45-degree field of view; fundus photo; 2212x1672px
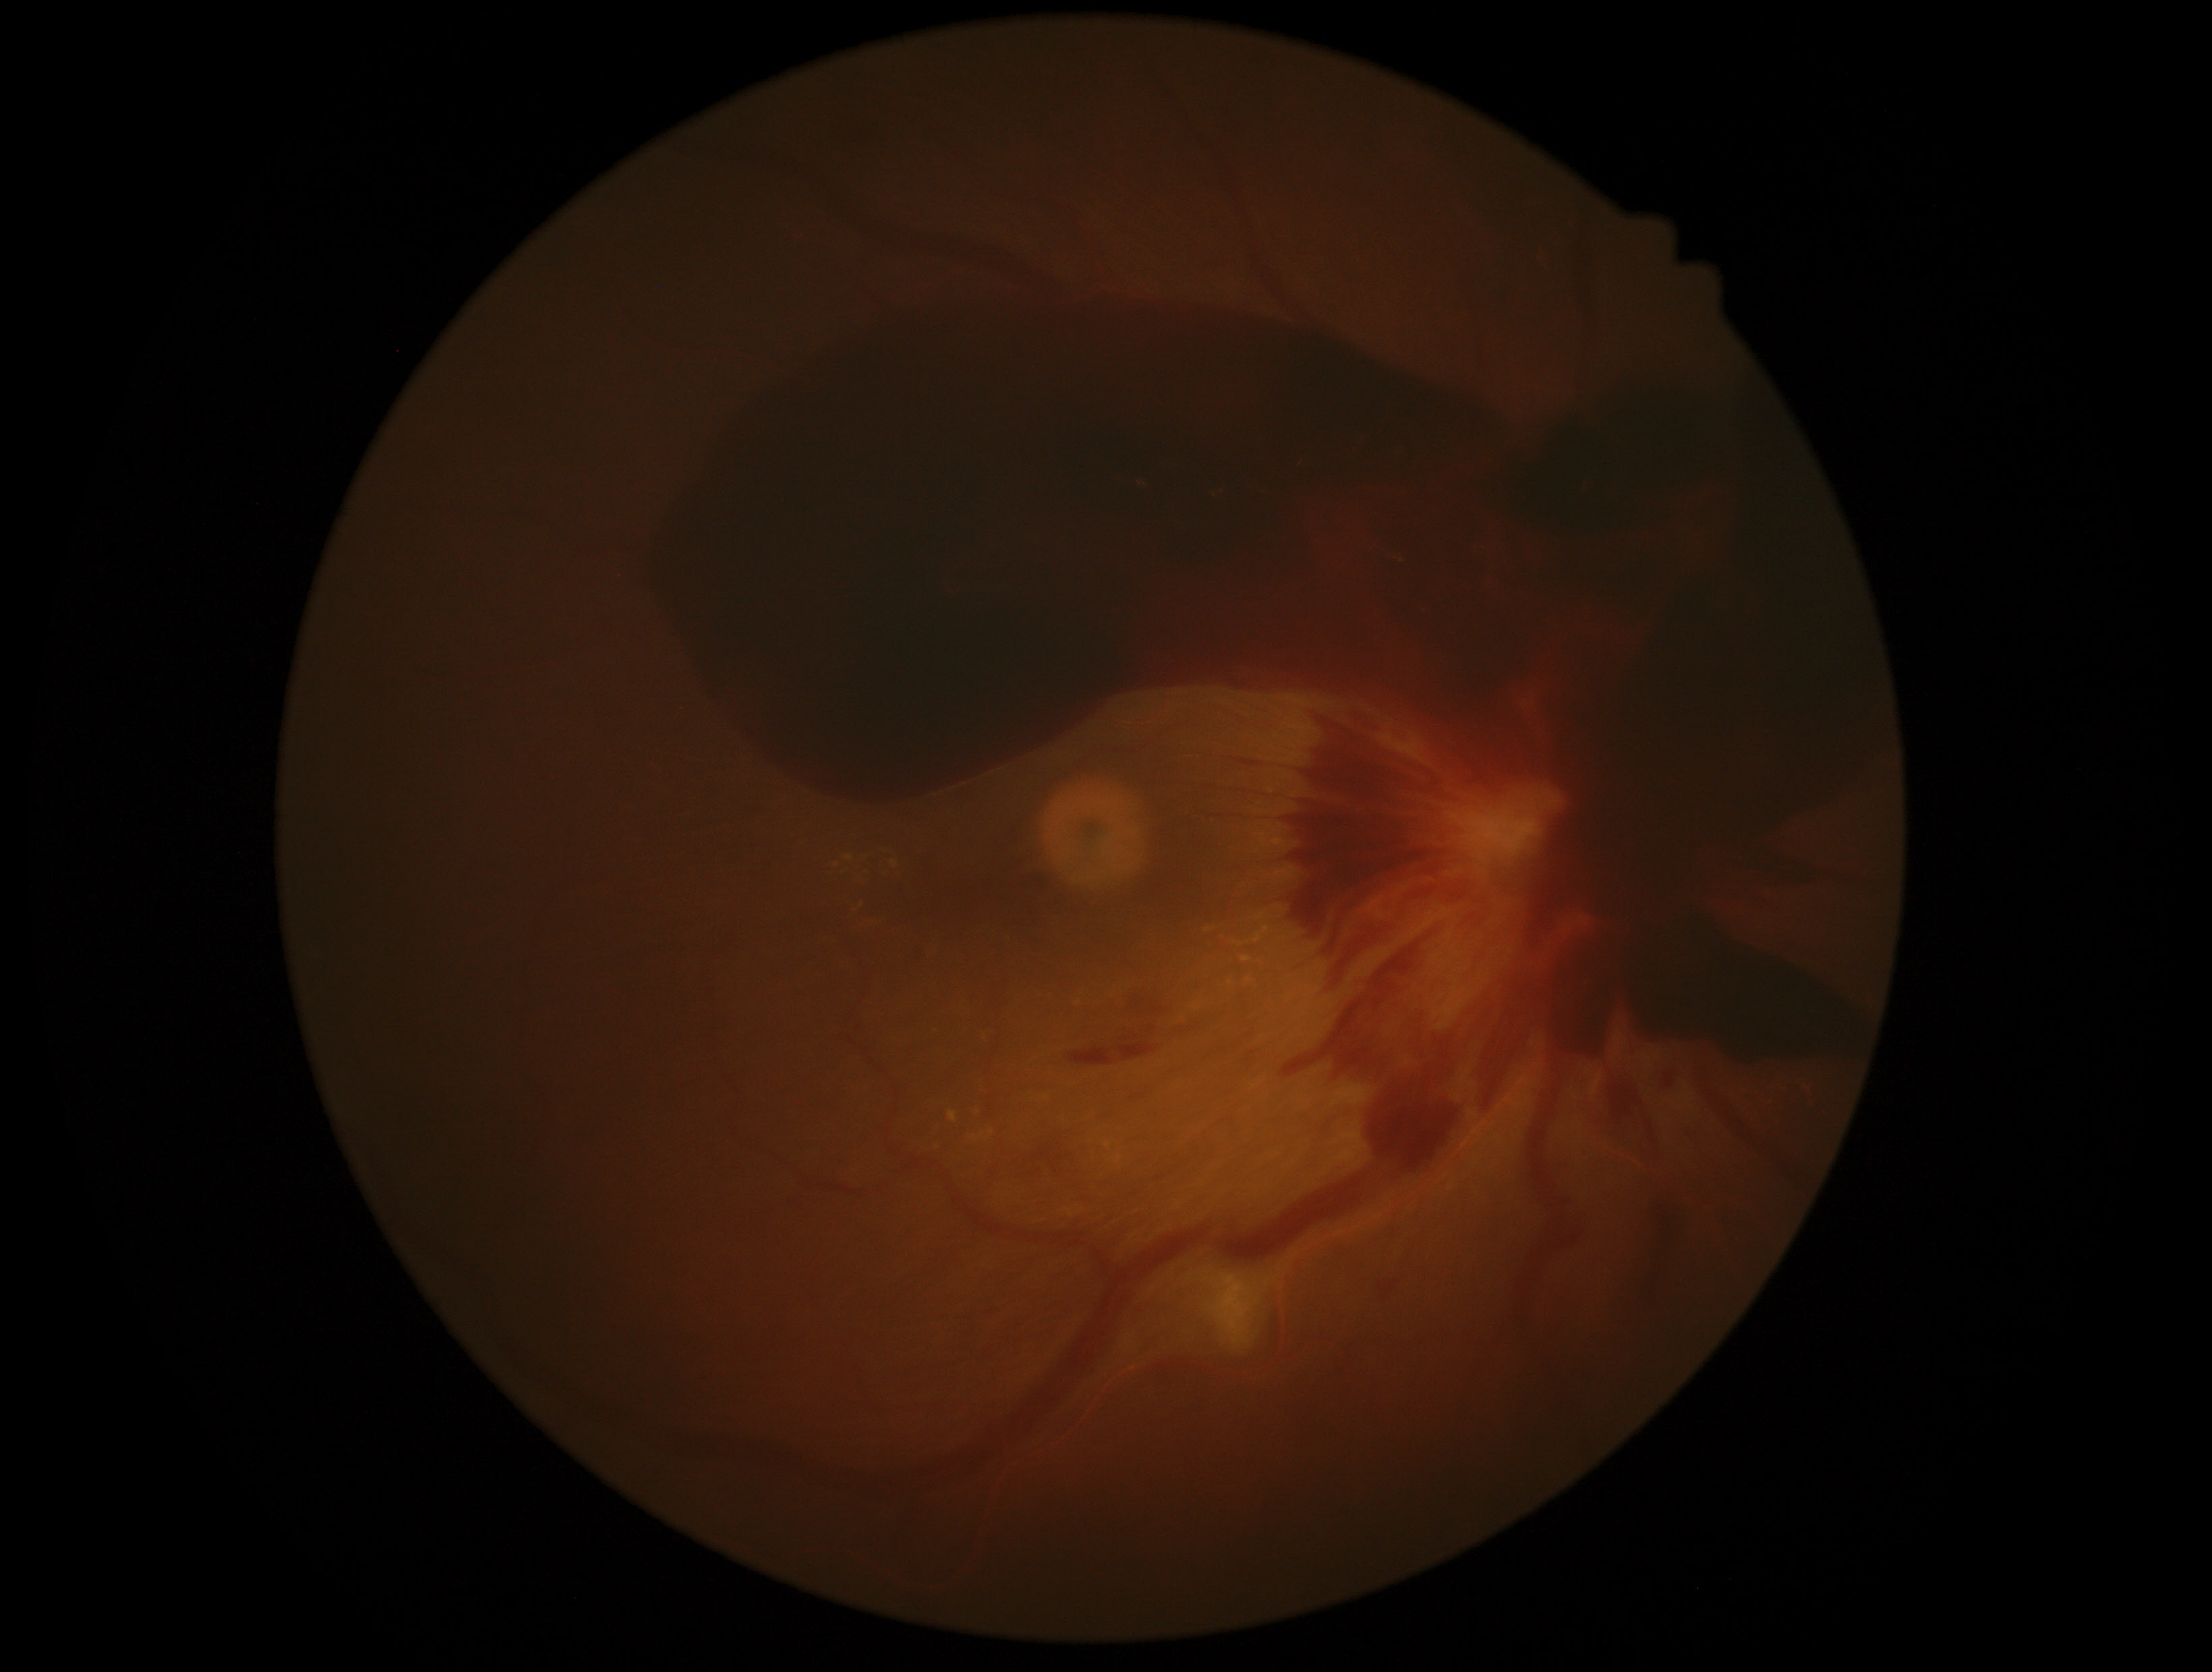

– DR — grade 4 (PDR)